Wide-field contact fundus photograph of an infant — 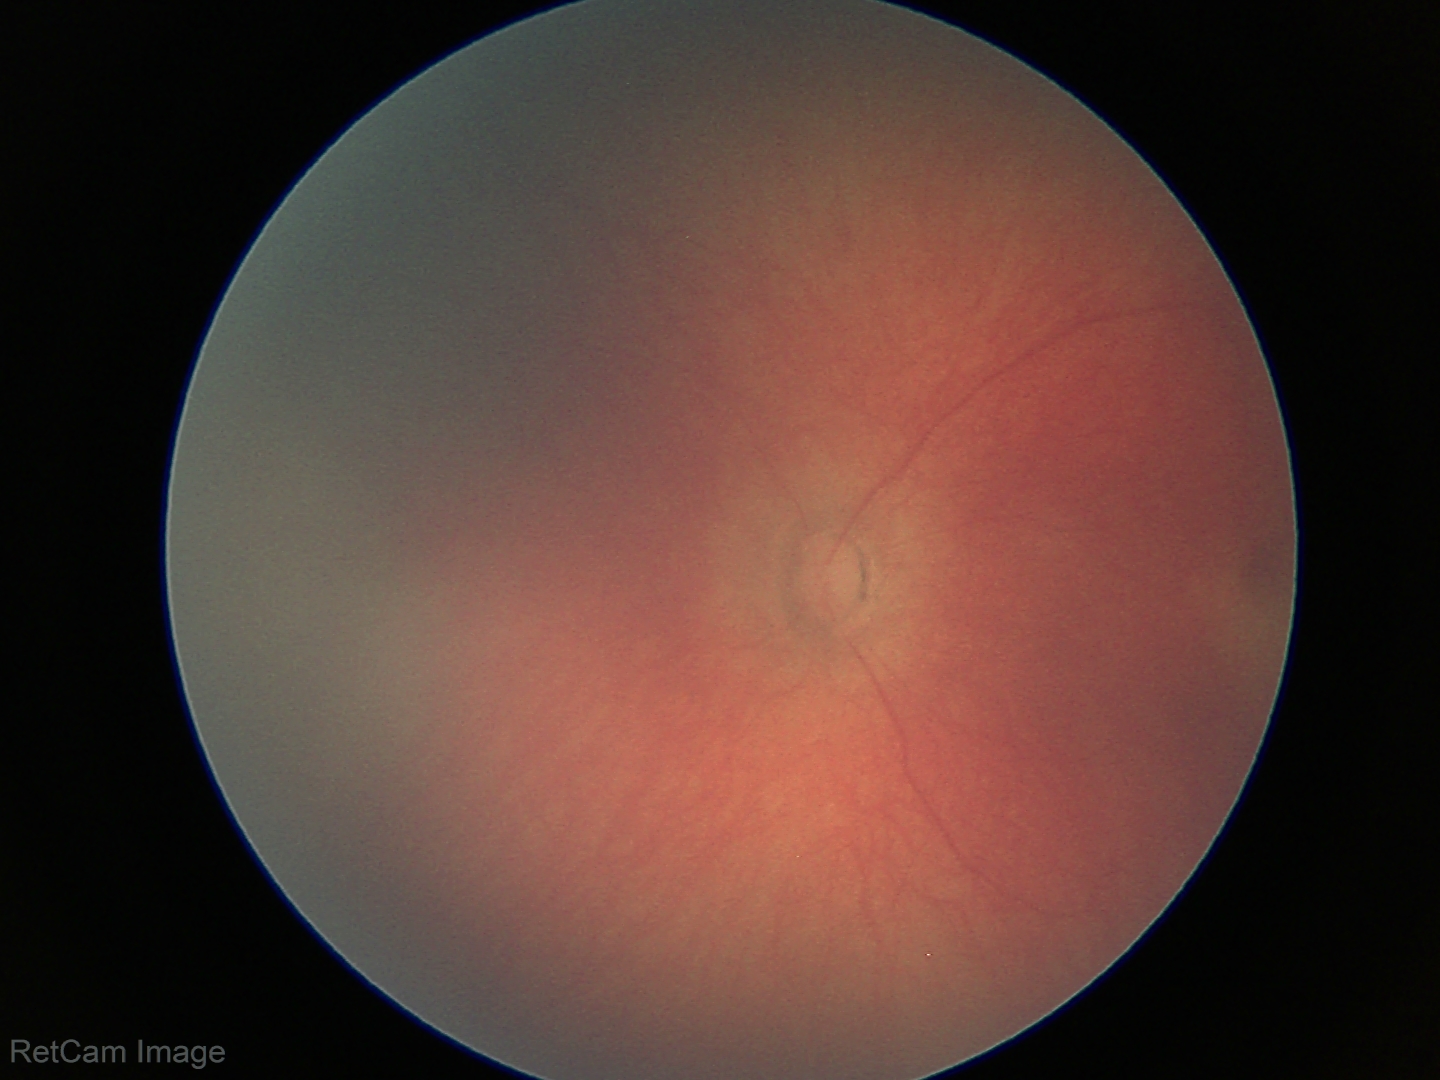
Examination with physiological retinal findings.